Clarity RetCam 3, 130° FOV · infant wide-field retinal image:
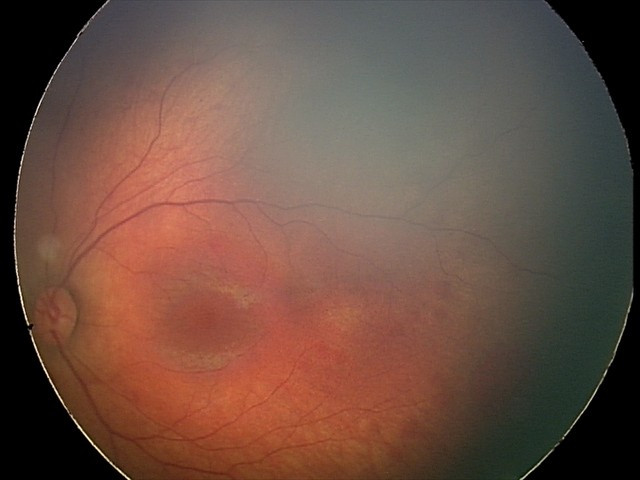
Series diagnosed as retinal hemorrhages.